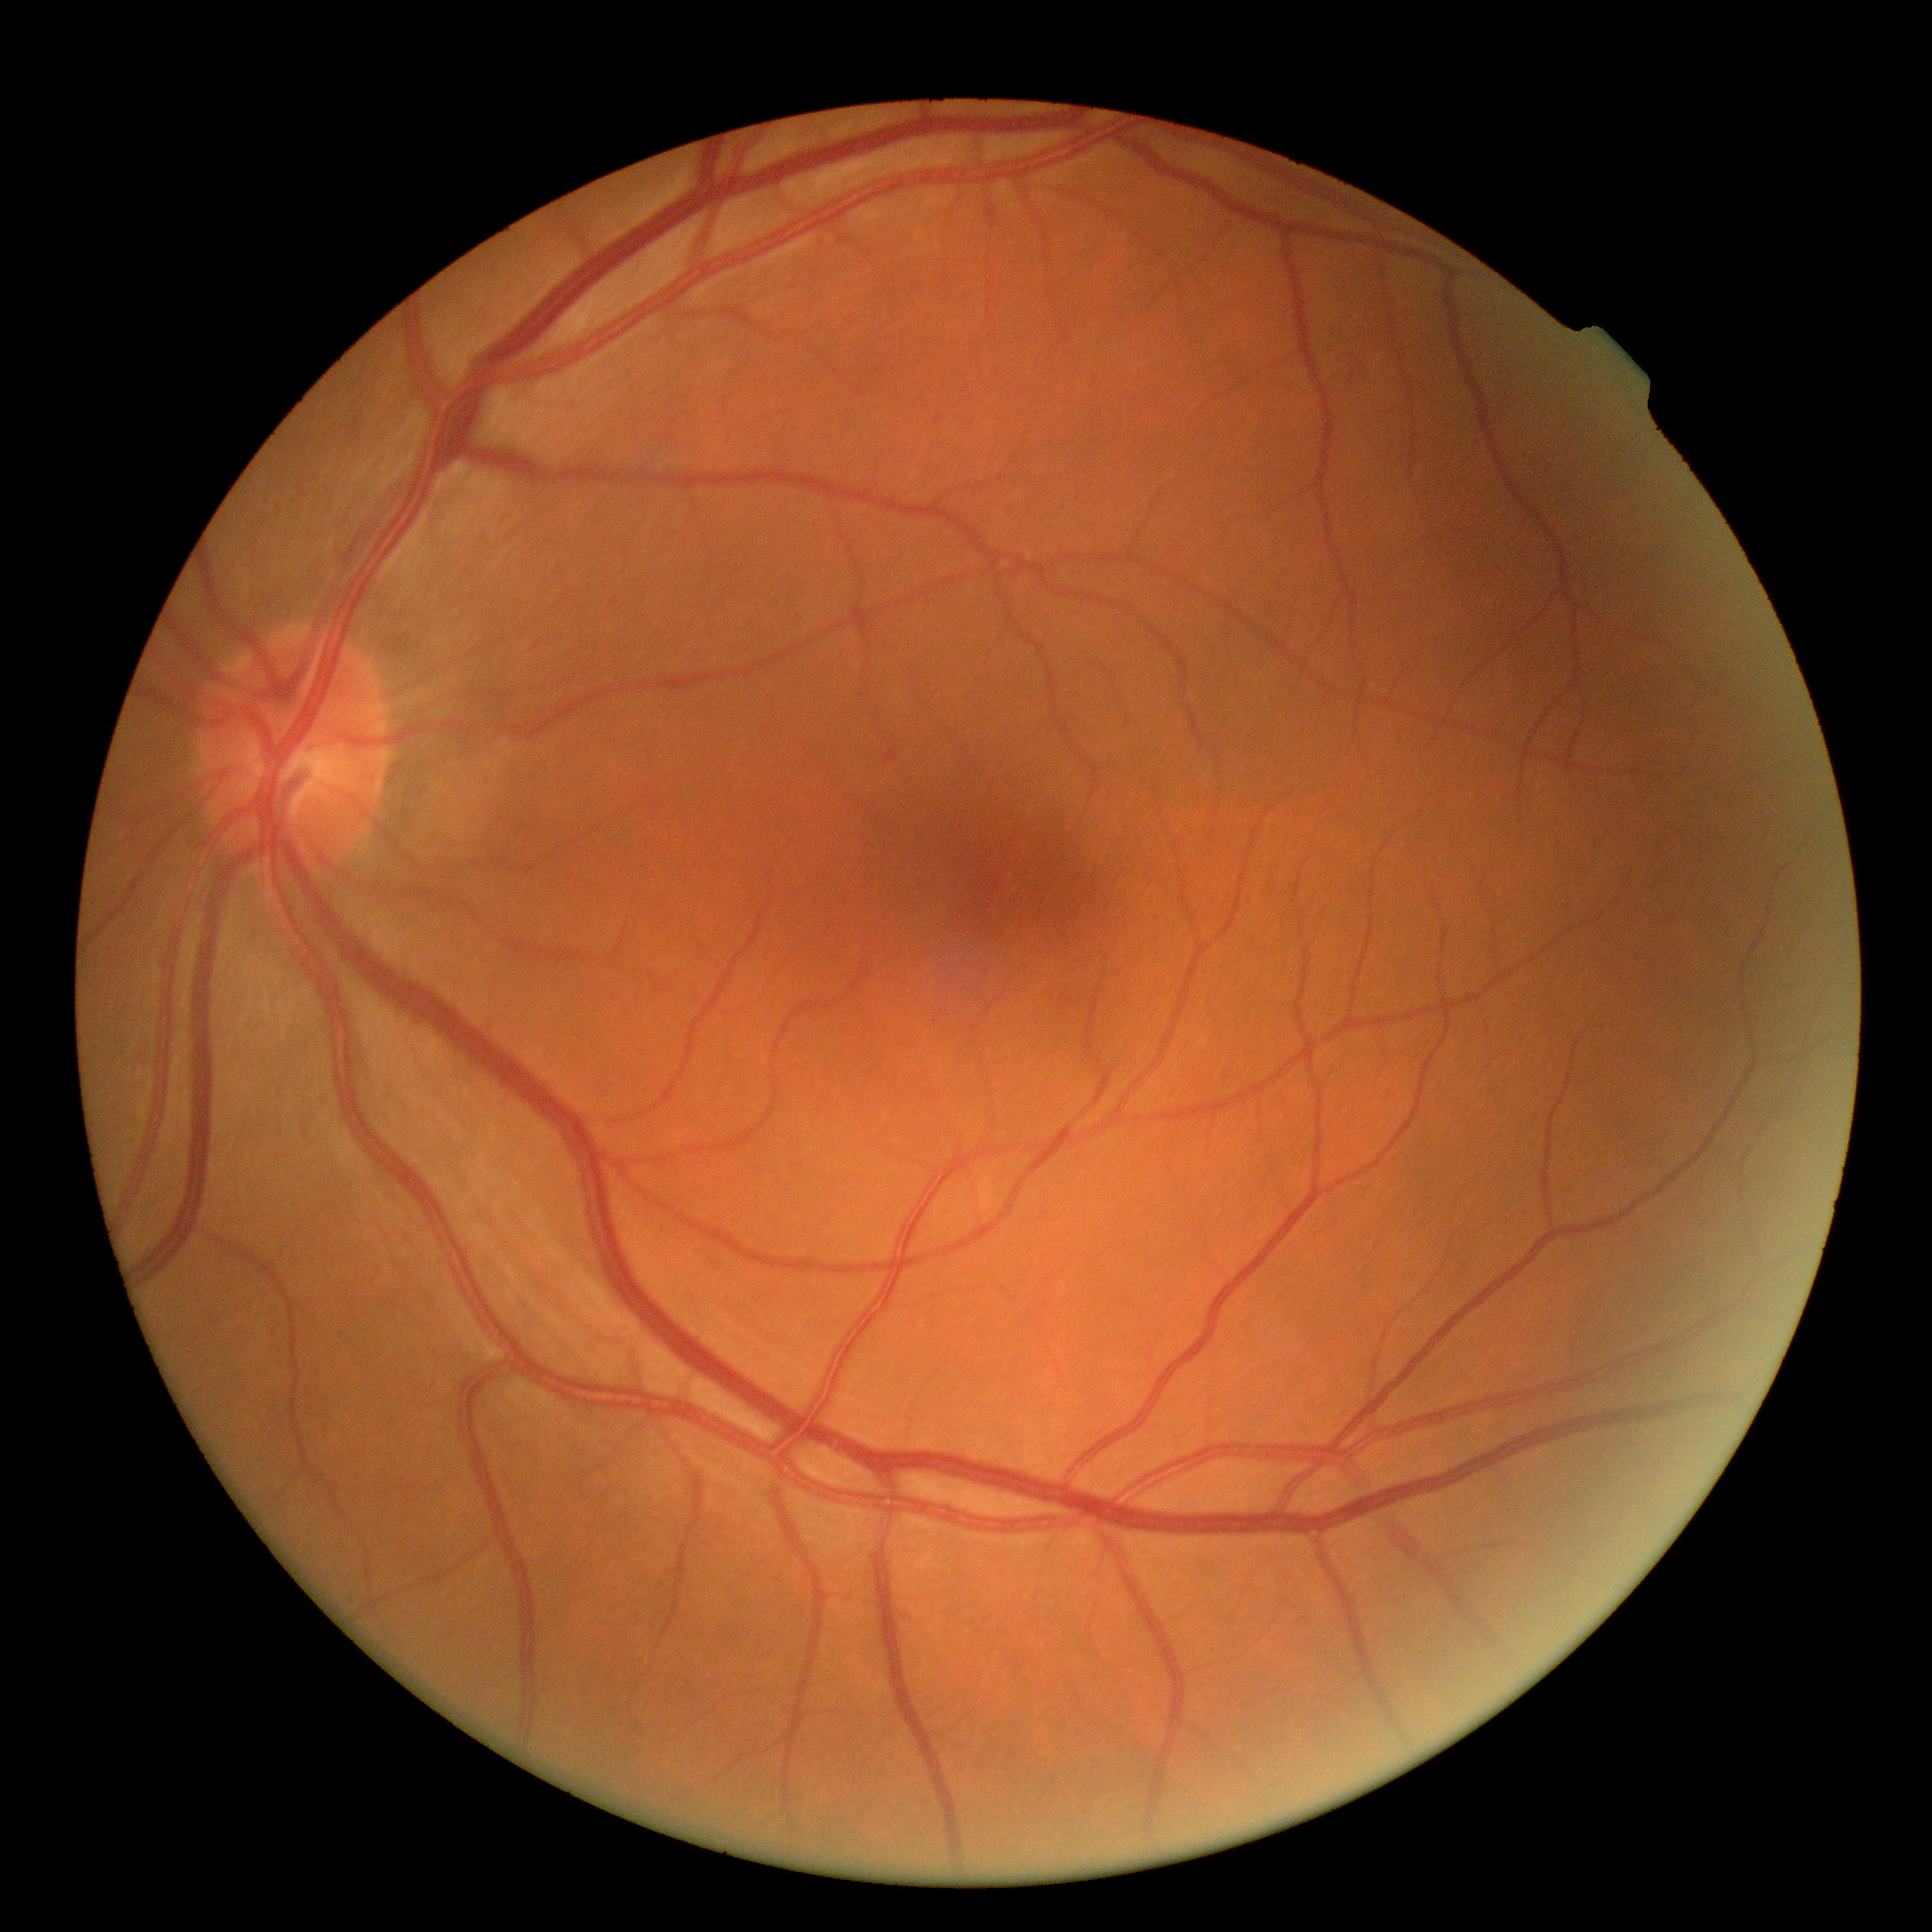
DR impression: negative for DR, diabetic retinopathy grade: 0.